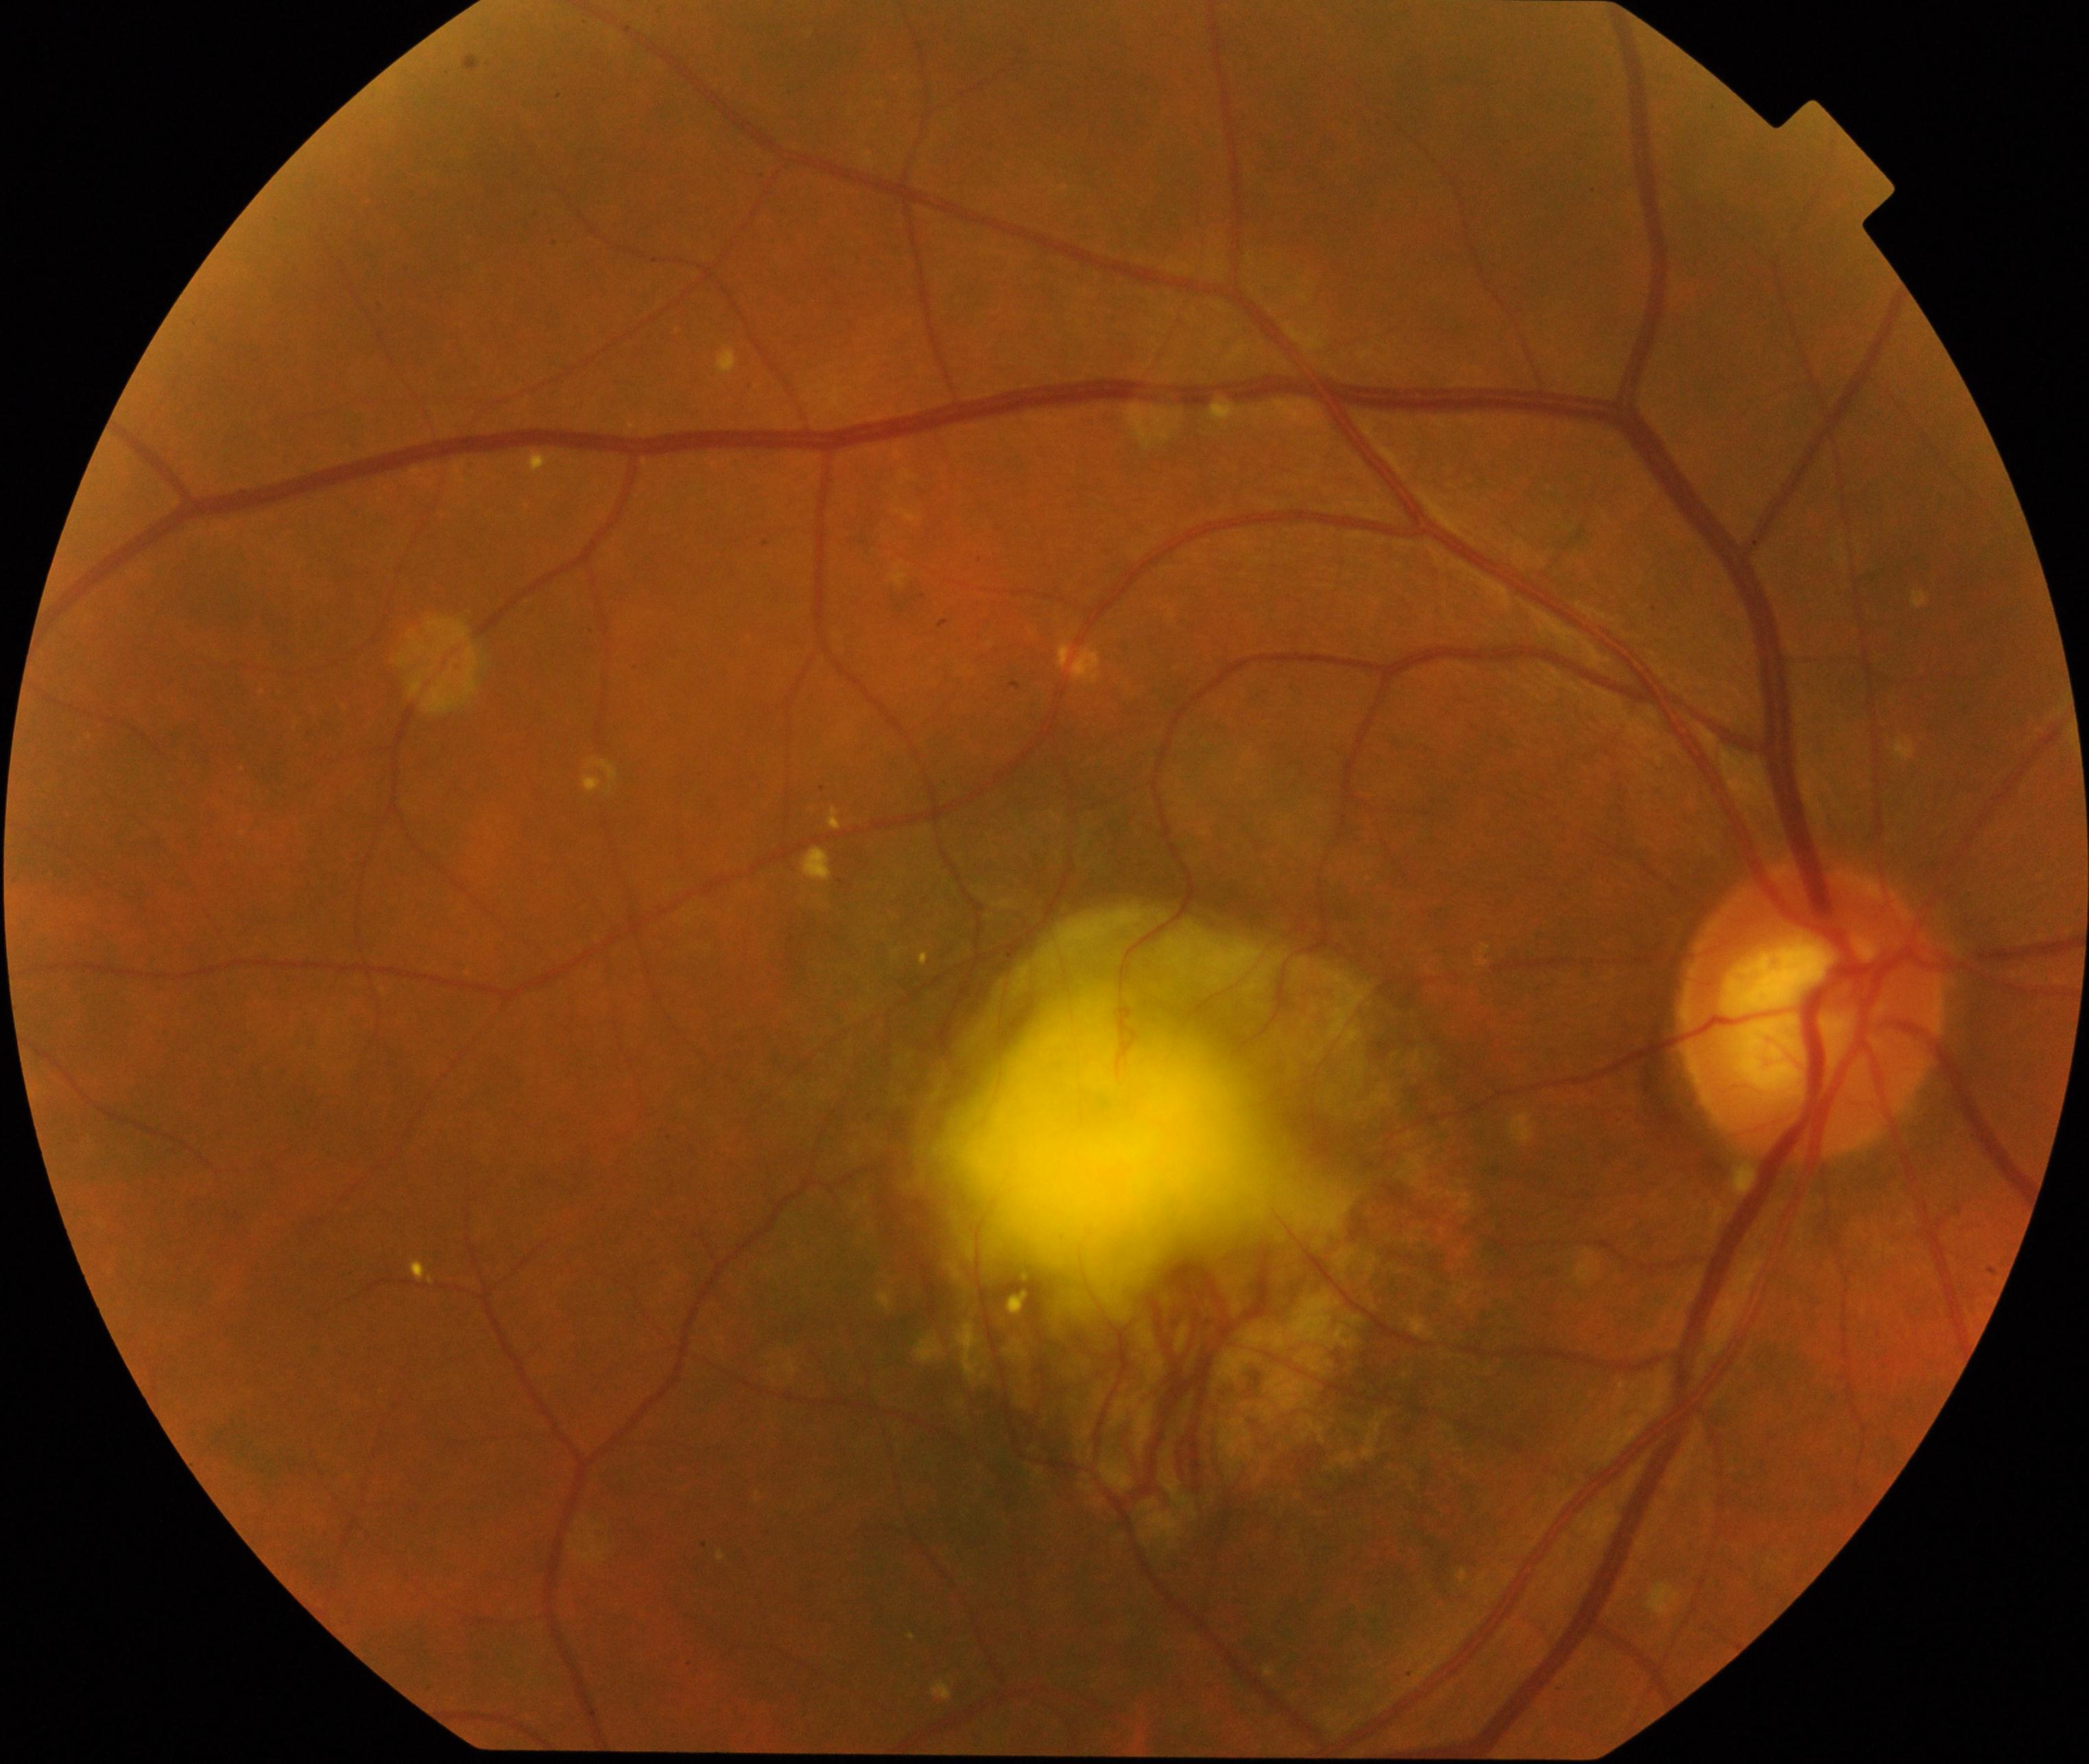
Primary finding: maculopathy.